NIDEK AFC-230 fundus camera. 45° FOV. Modified Davis grading — 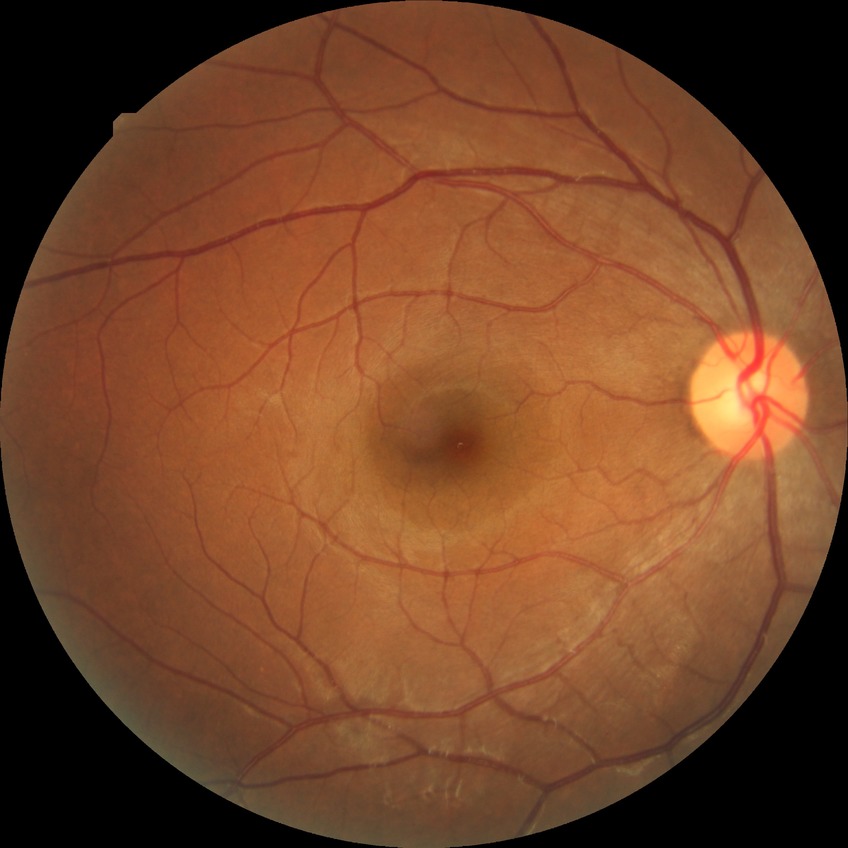
DR is NDR.